130° field of view (Clarity RetCam 3). Wide-field fundus photograph of an infant:
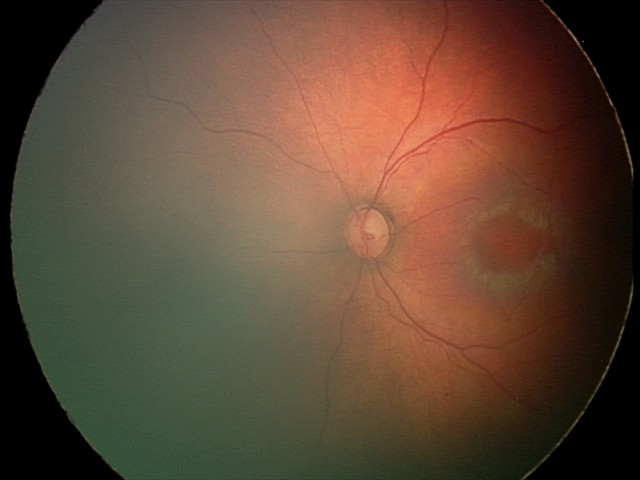
No retinal pathology identified on screening.